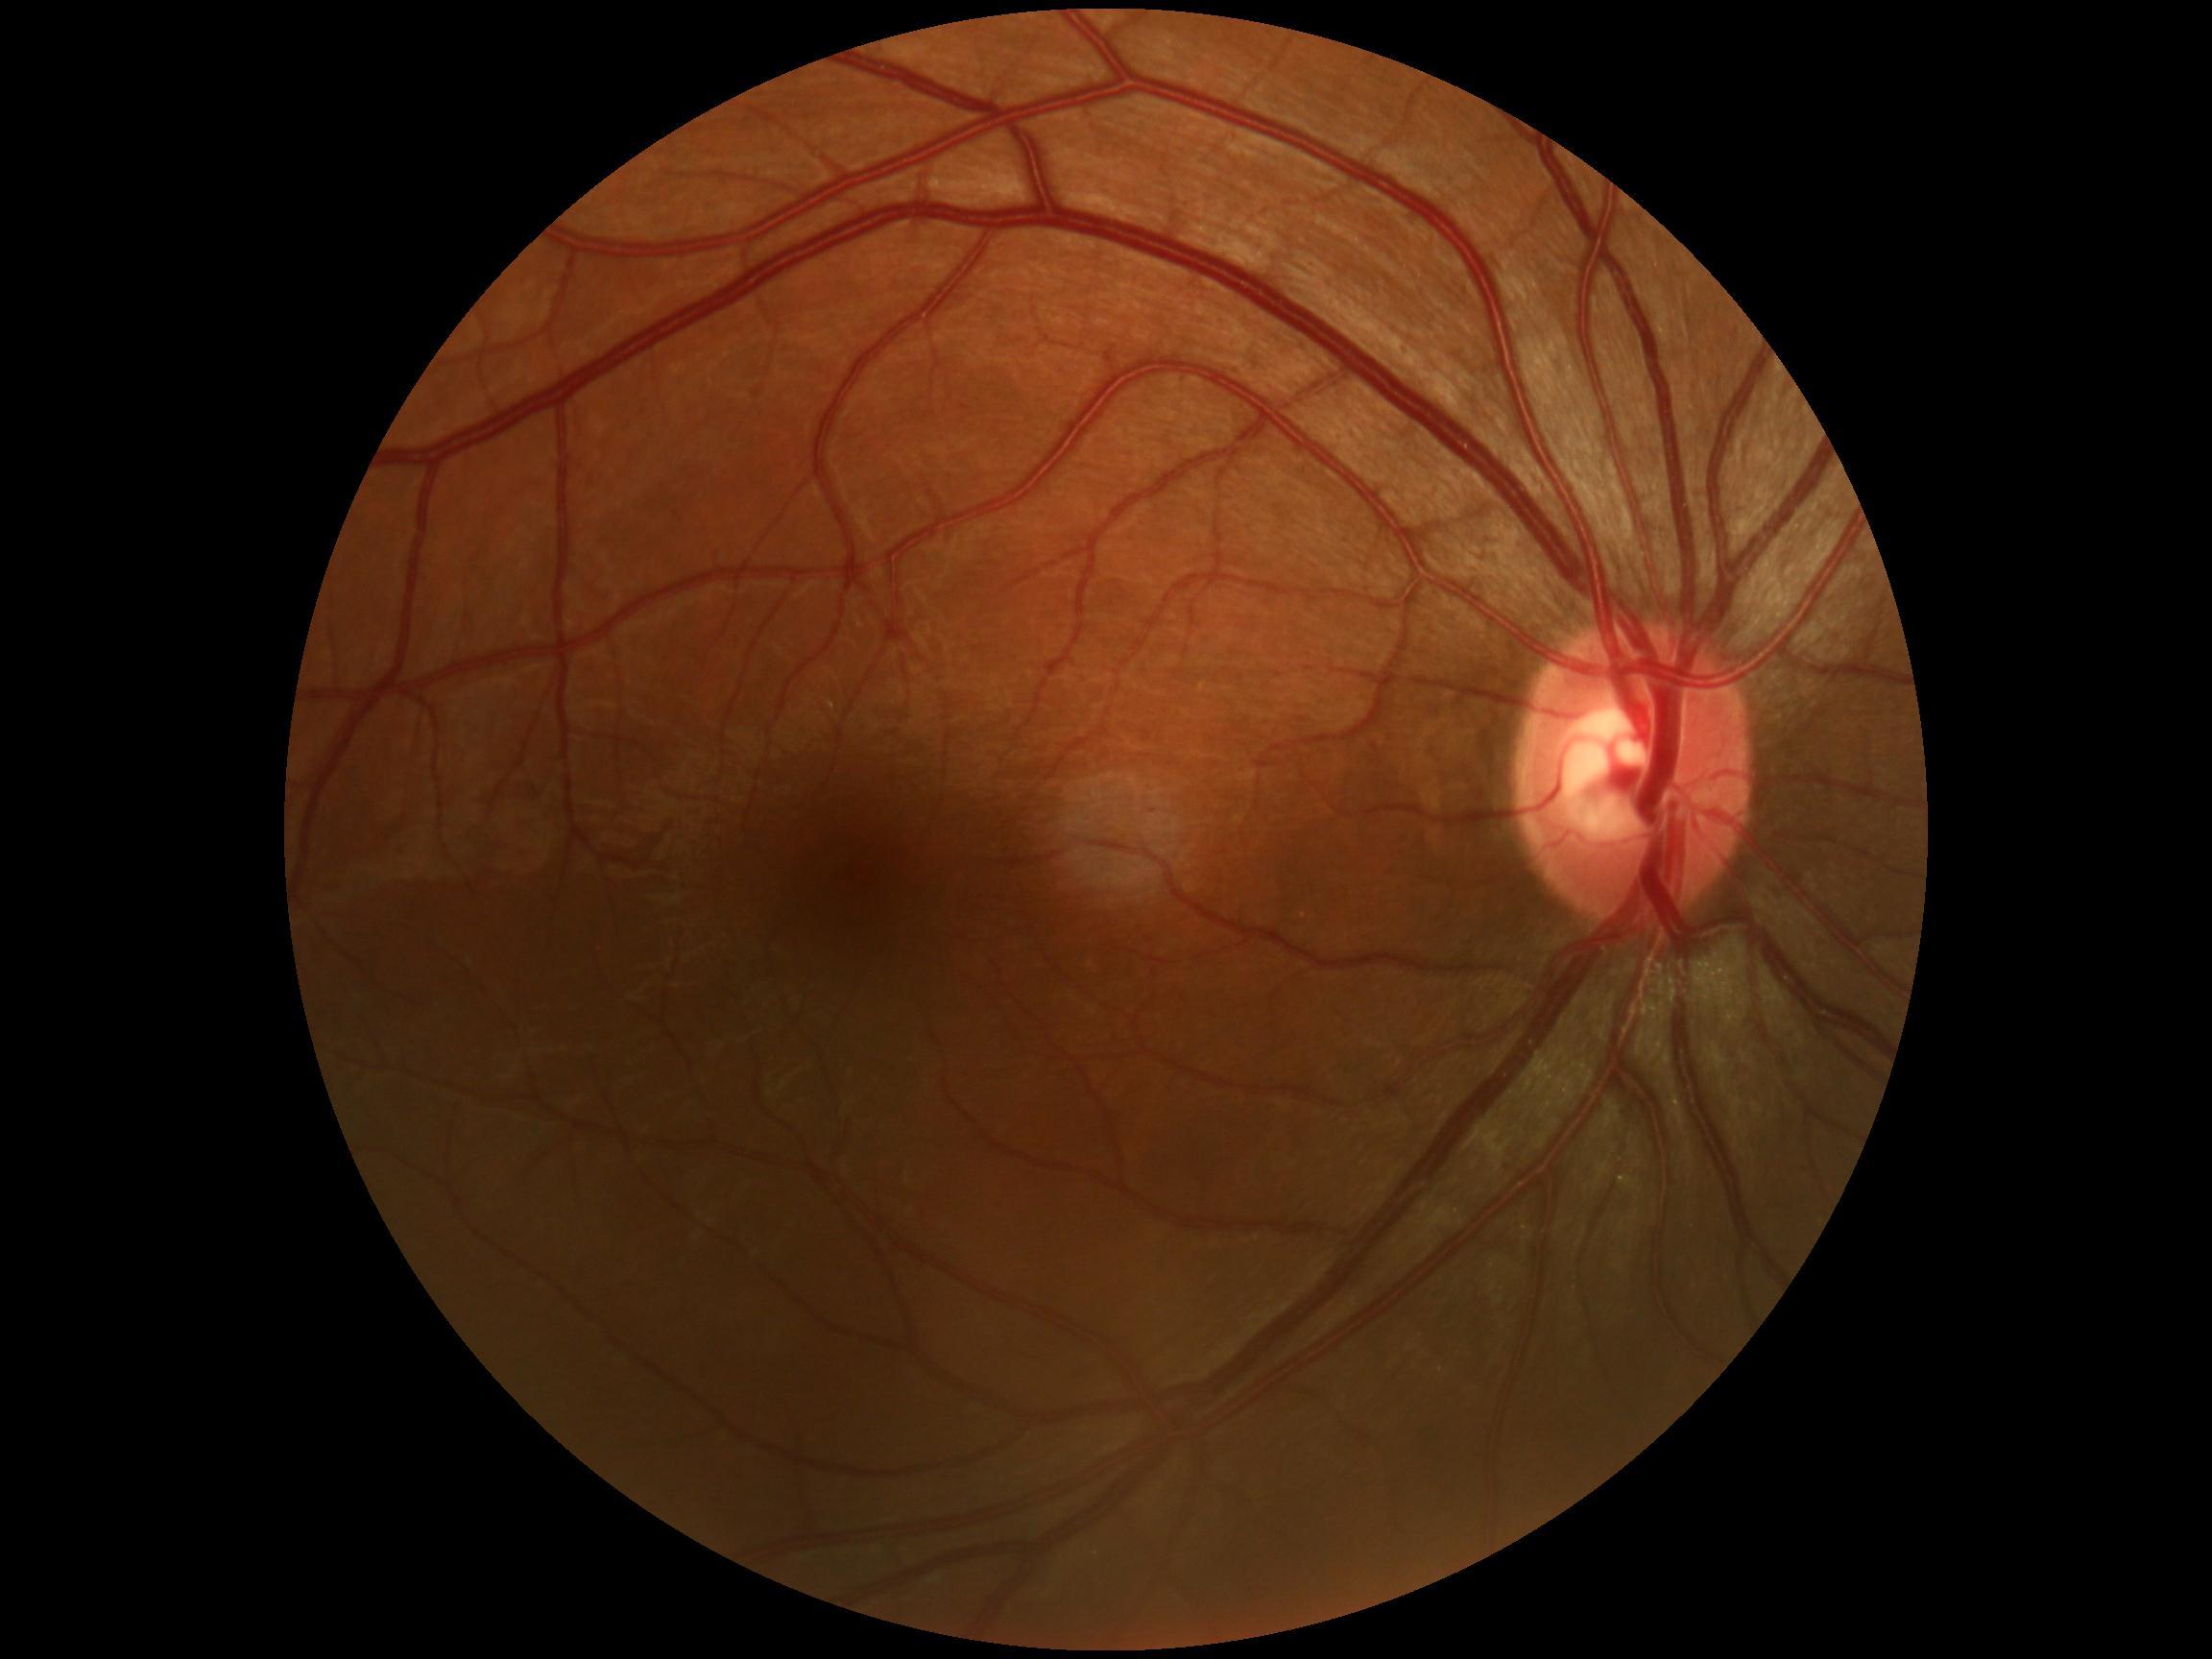

Diabetic retinopathy grade is no apparent diabetic retinopathy (0).